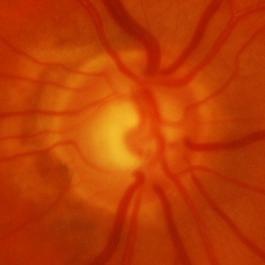
Optic disc photograph showing evidence of glaucoma.